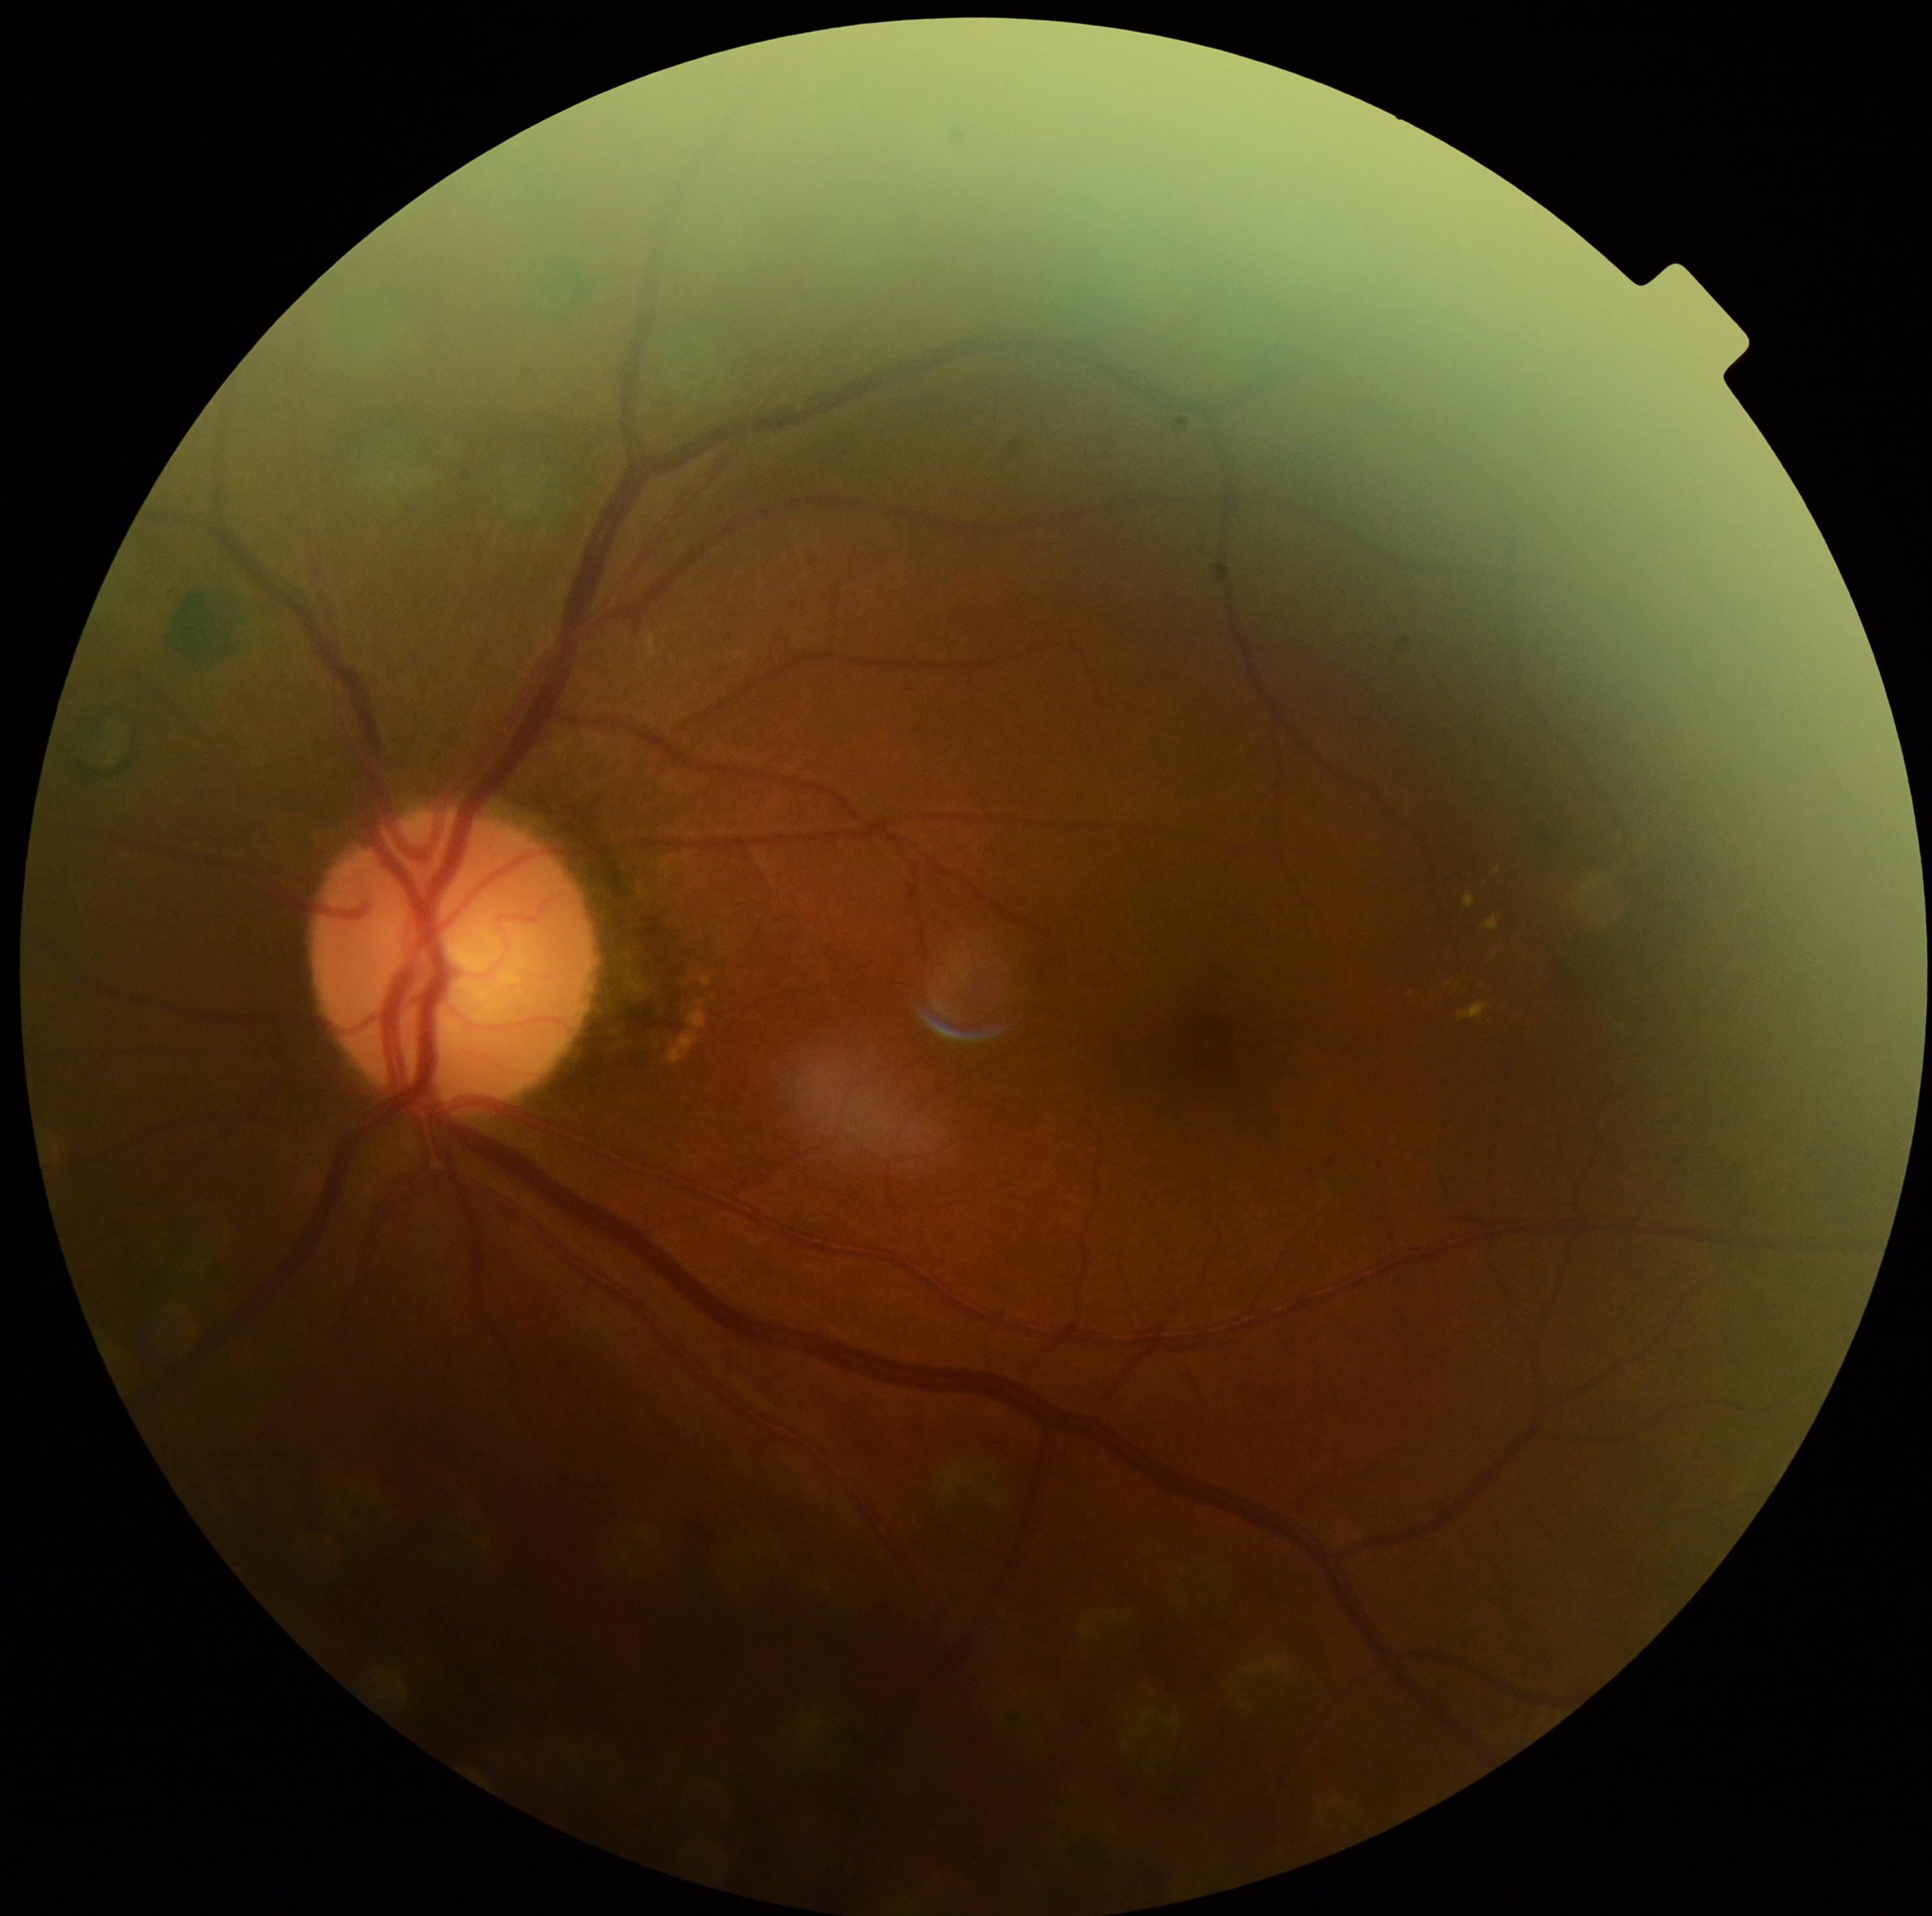

diabetic retinopathy grade: 2 — more than just microaneurysms but less than severe NPDR.